Camera: Natus RetCam Envision (130° FOV). Infant wide-field retinal image: 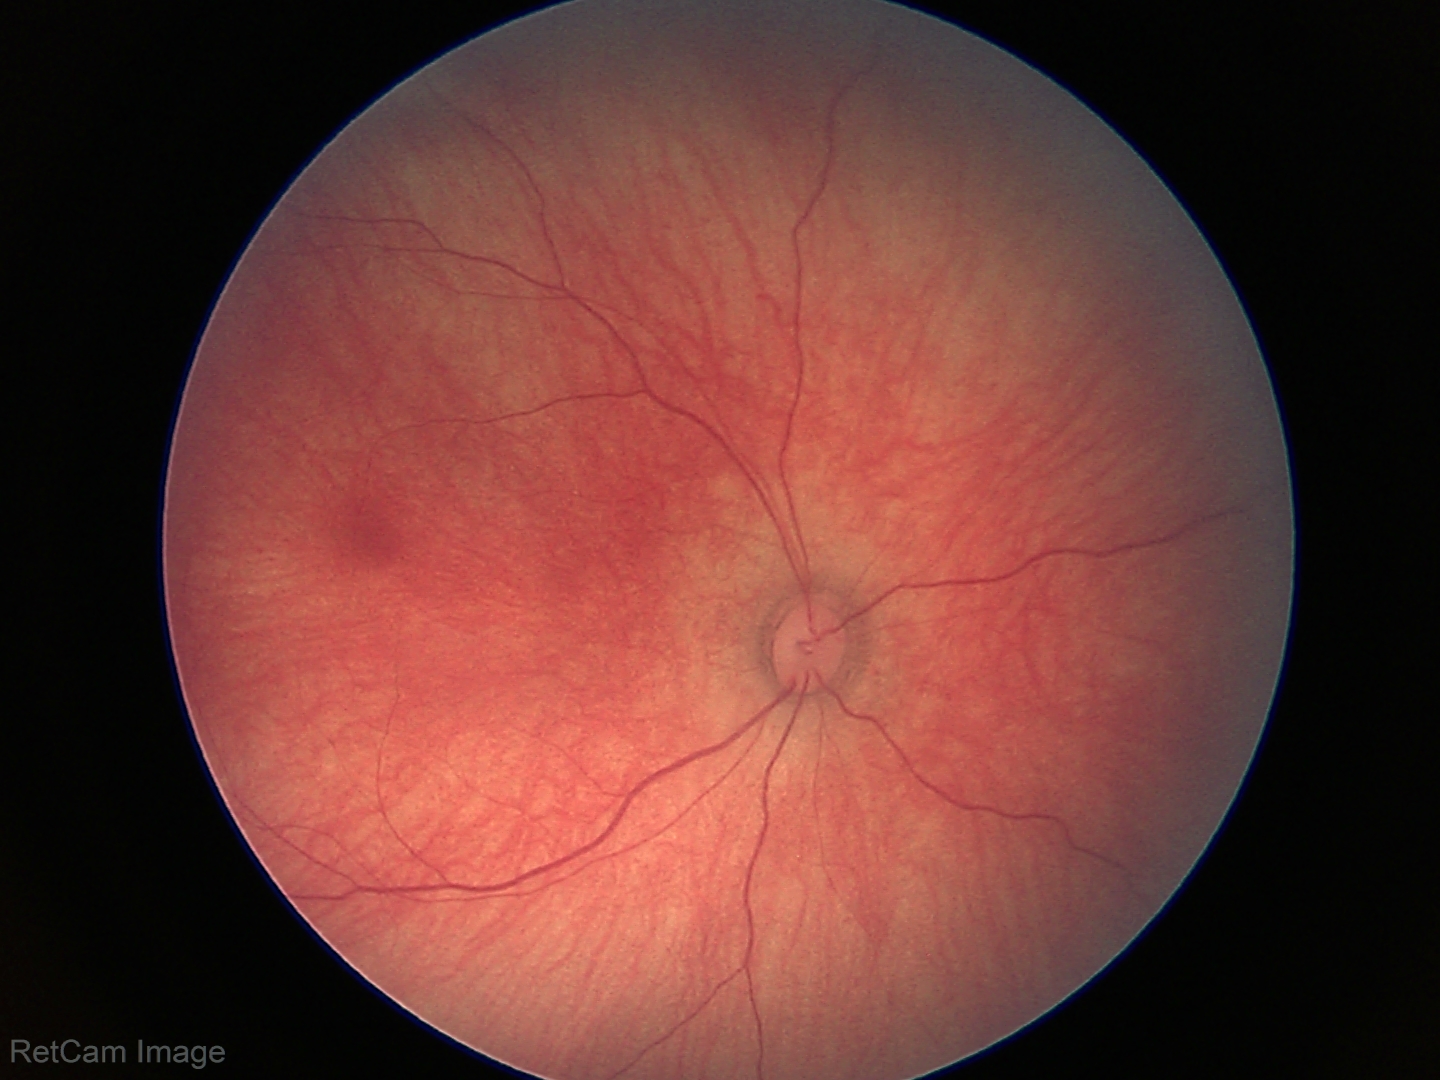

No retinal pathology identified on screening.